Without pupil dilation, posterior pole photograph
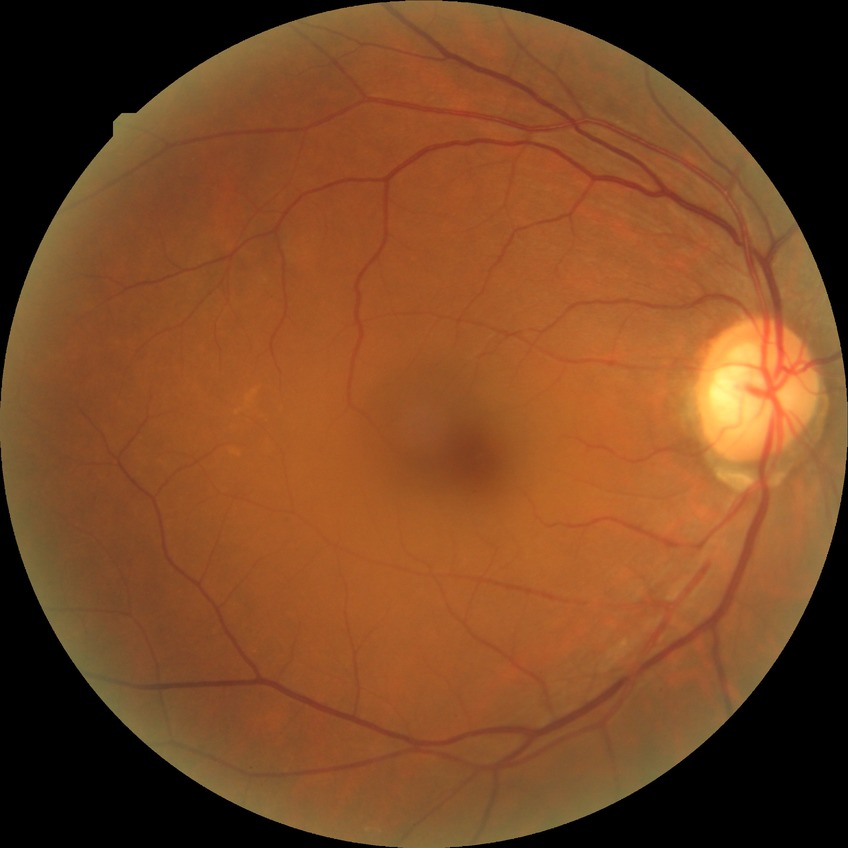
Diabetic retinopathy (DR) is no diabetic retinopathy (NDR).